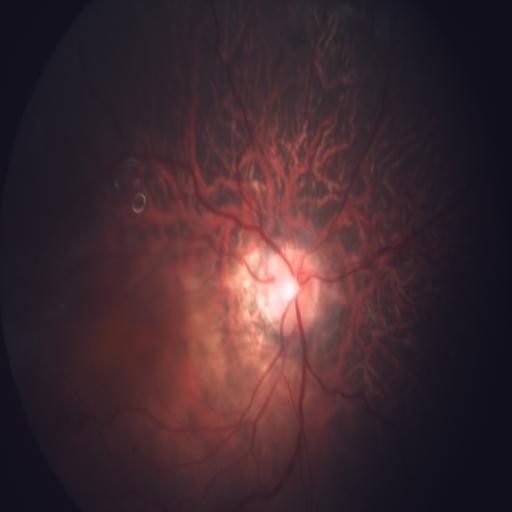
This fundus photograph shows MYA (myopia).